Nonmydriatic fundus photograph. NIDEK AFC-230. Modified Davis grading. FOV: 45 degrees: 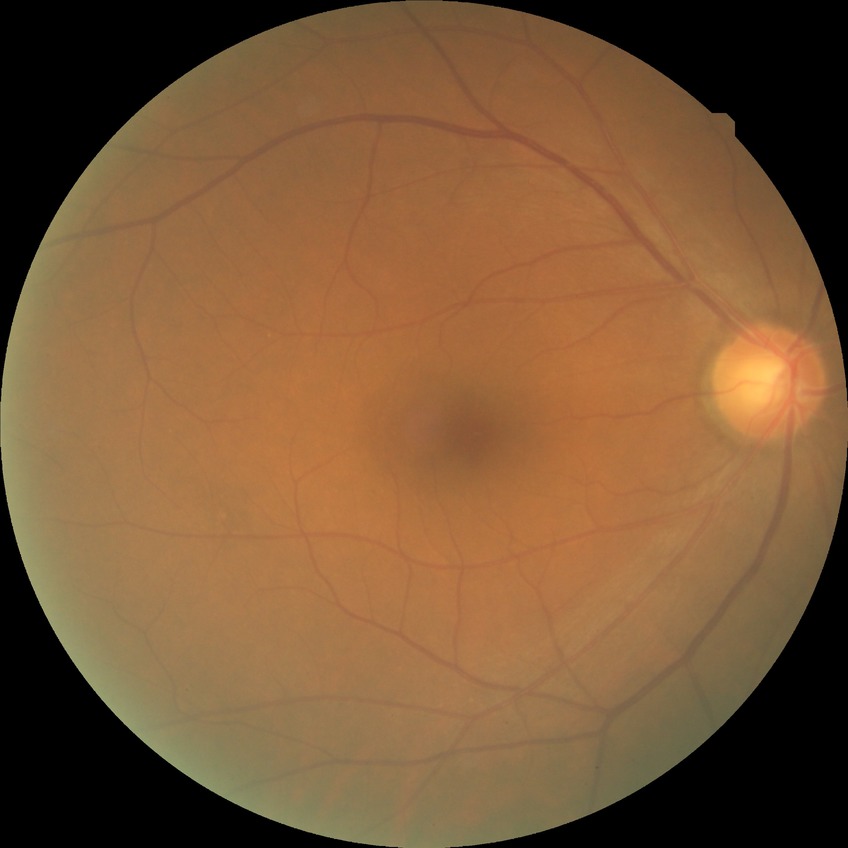 Modified Davis grade: NDR.
No DR findings.